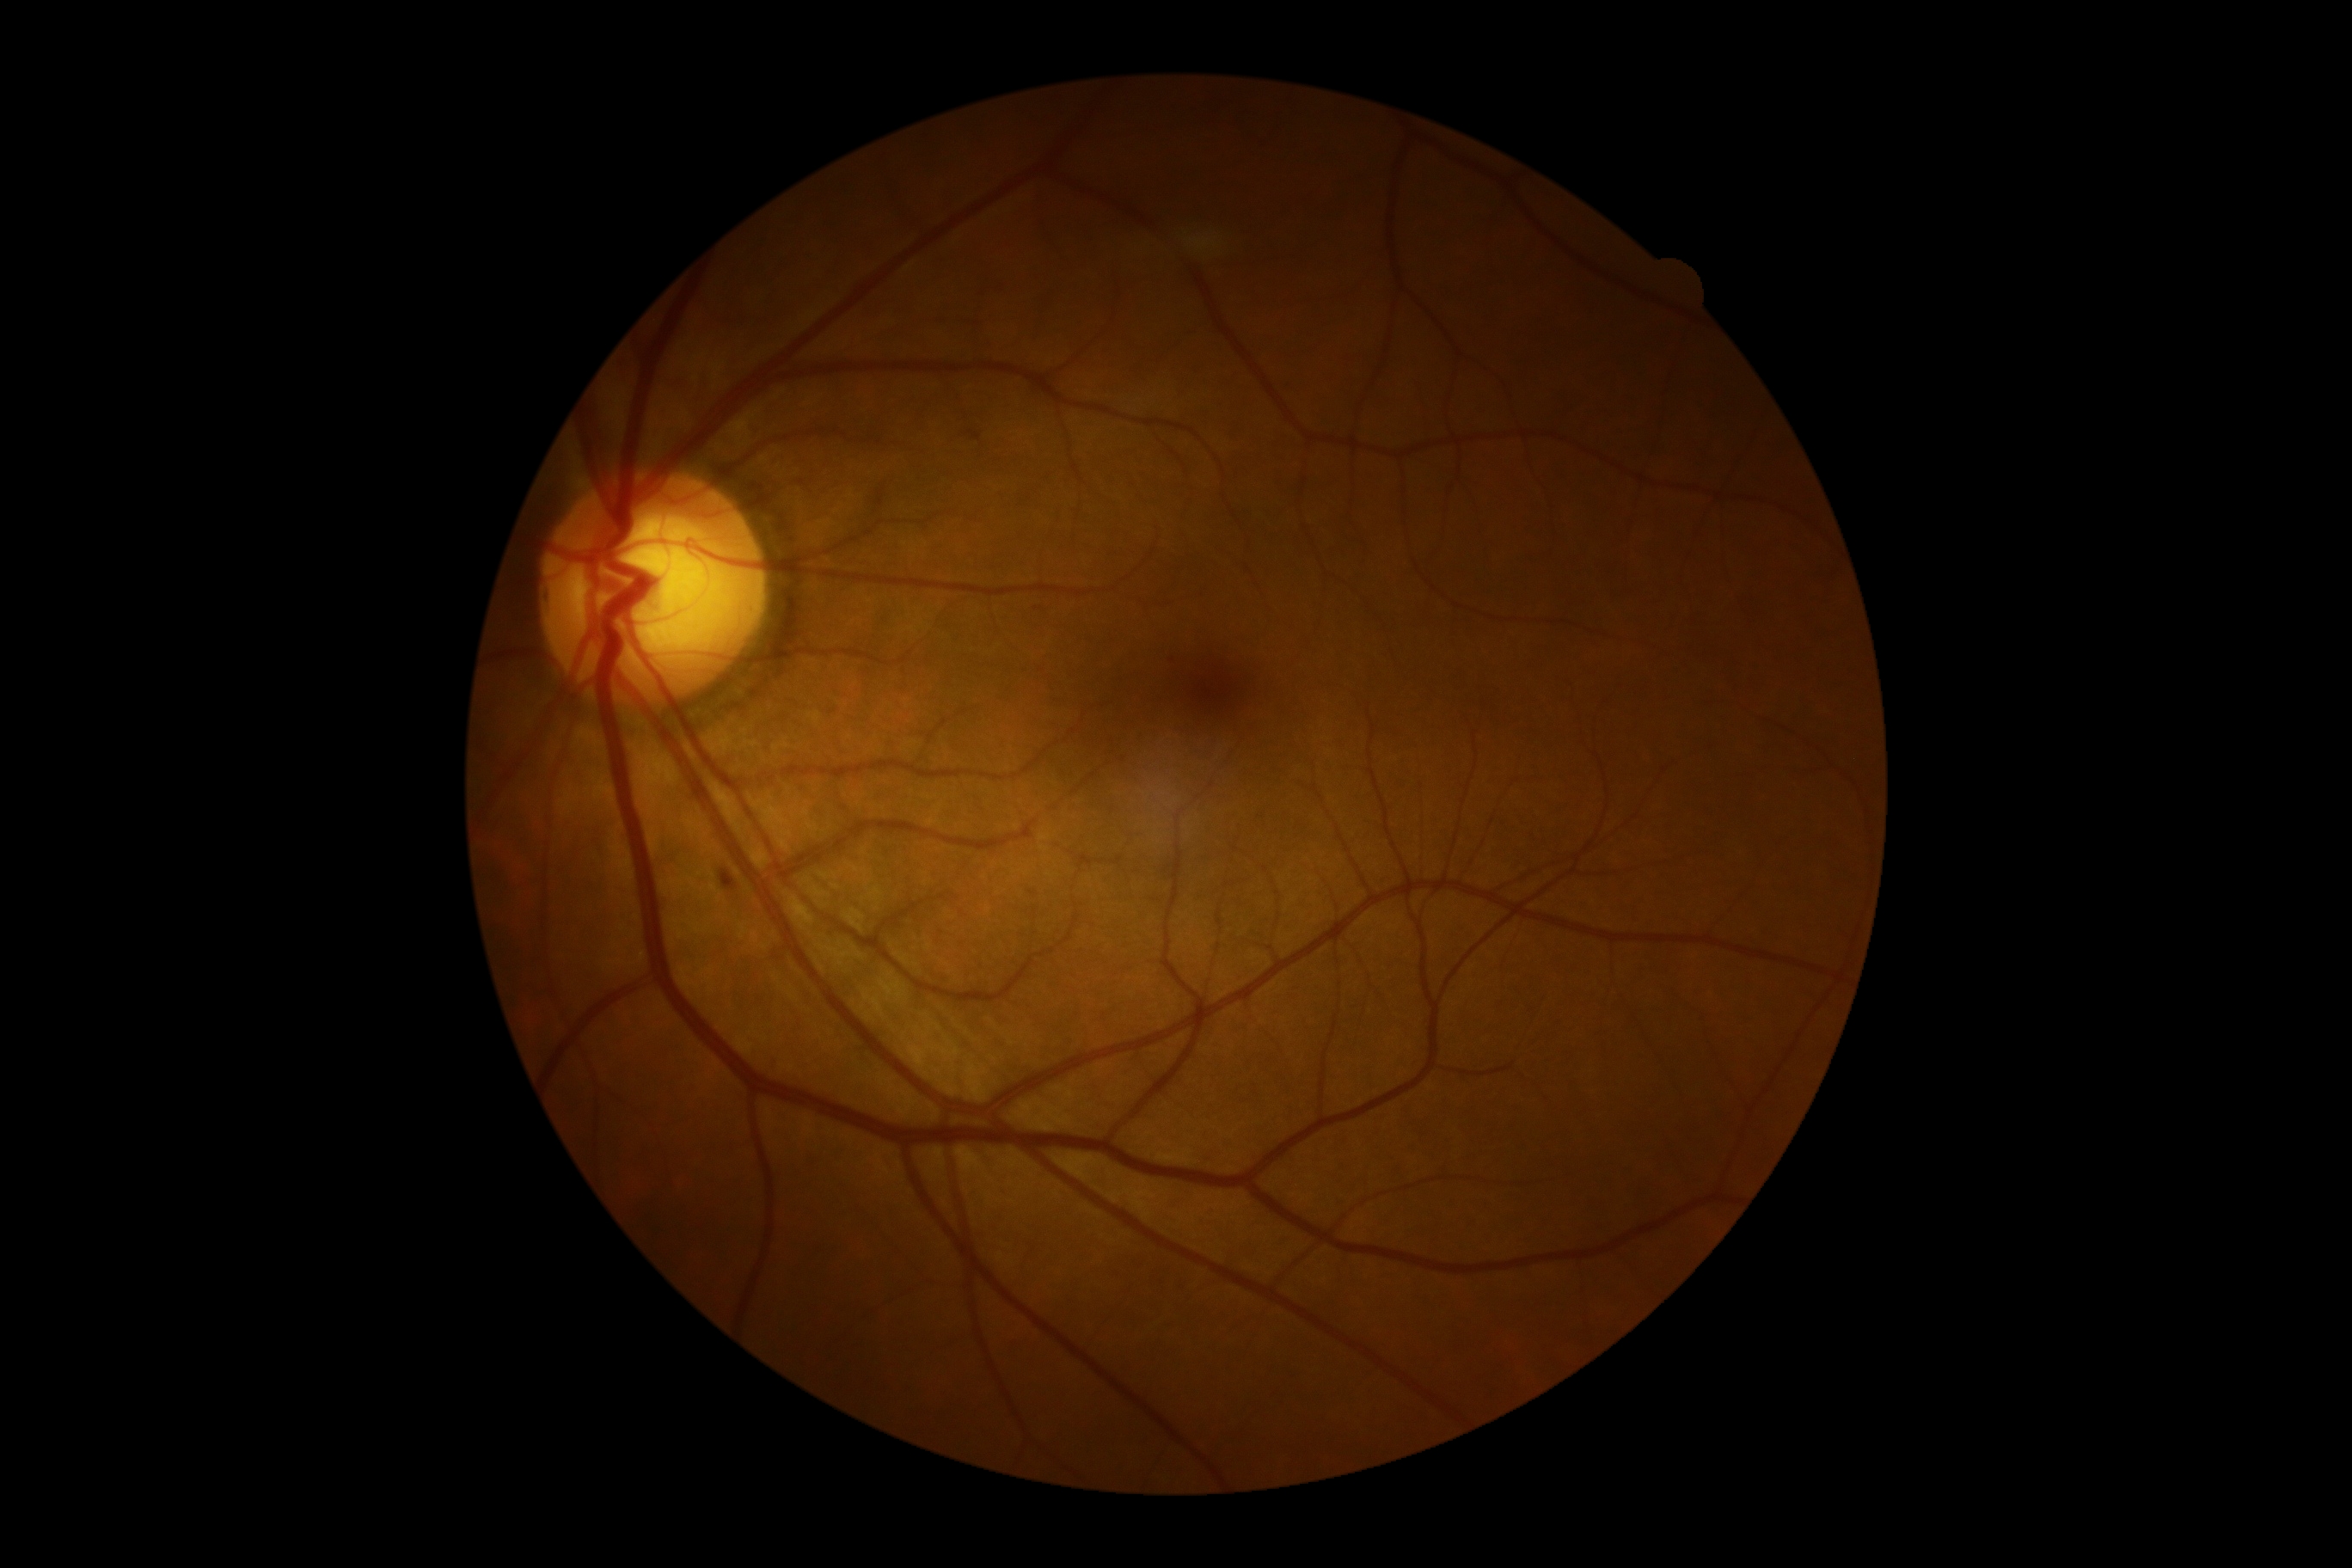 Findings:
– DR severity: moderate non-proliferative diabetic retinopathy (grade 2)